Color fundus image; 1659x2212
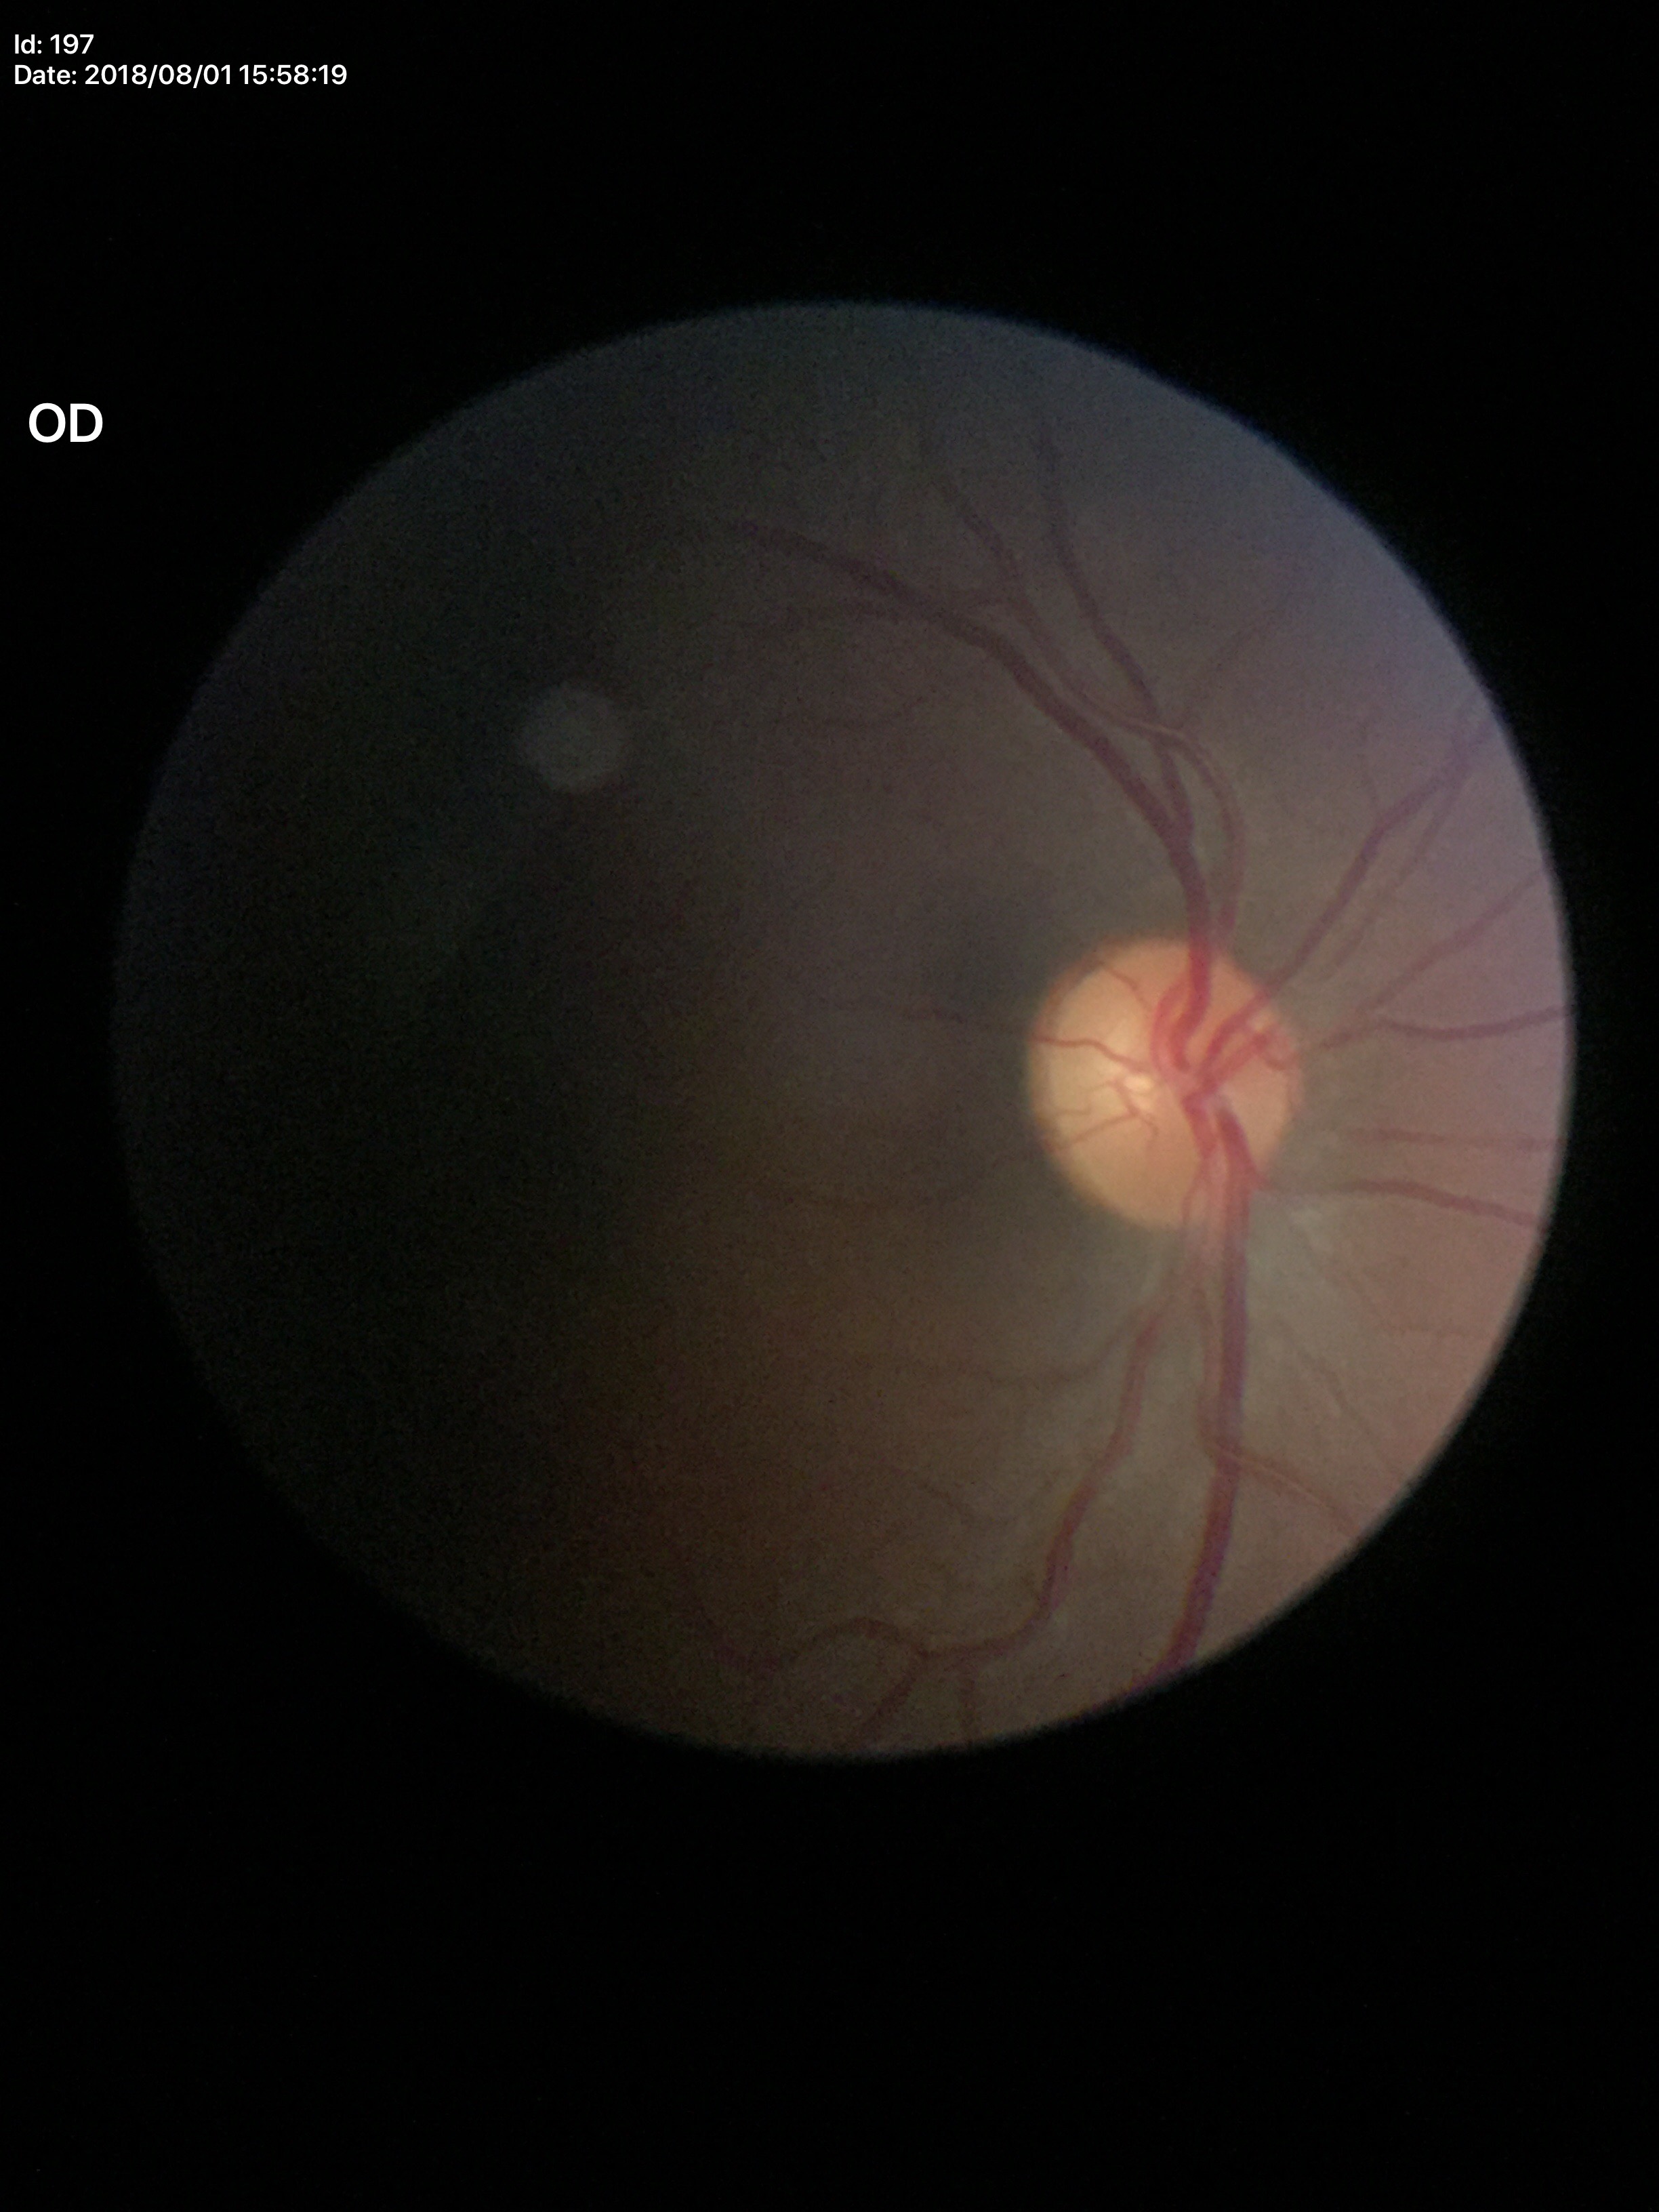
Vertical CDR (VCDR) is 0.41. No evidence of glaucoma (unanimous normal call).